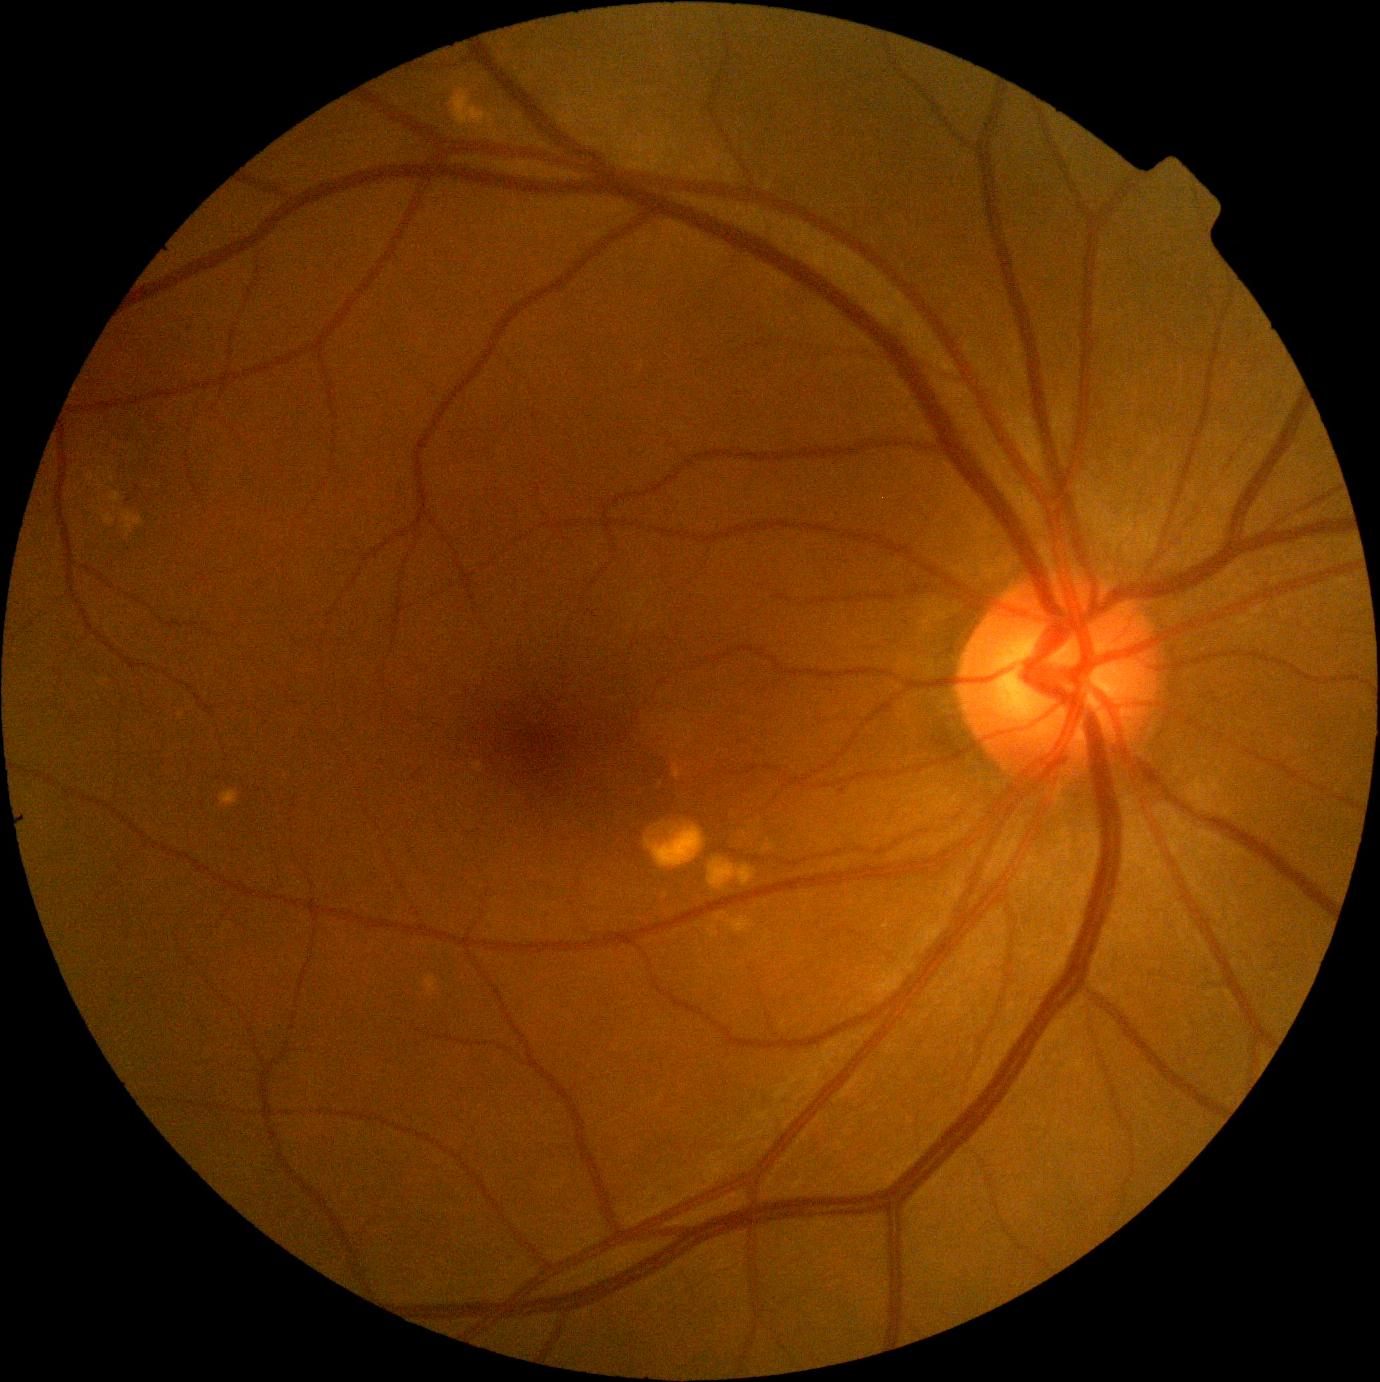

retinopathy grade: 0/4 — no visible signs of diabetic retinopathy | DR impression: no DR findings.